Image size 2352x1568: 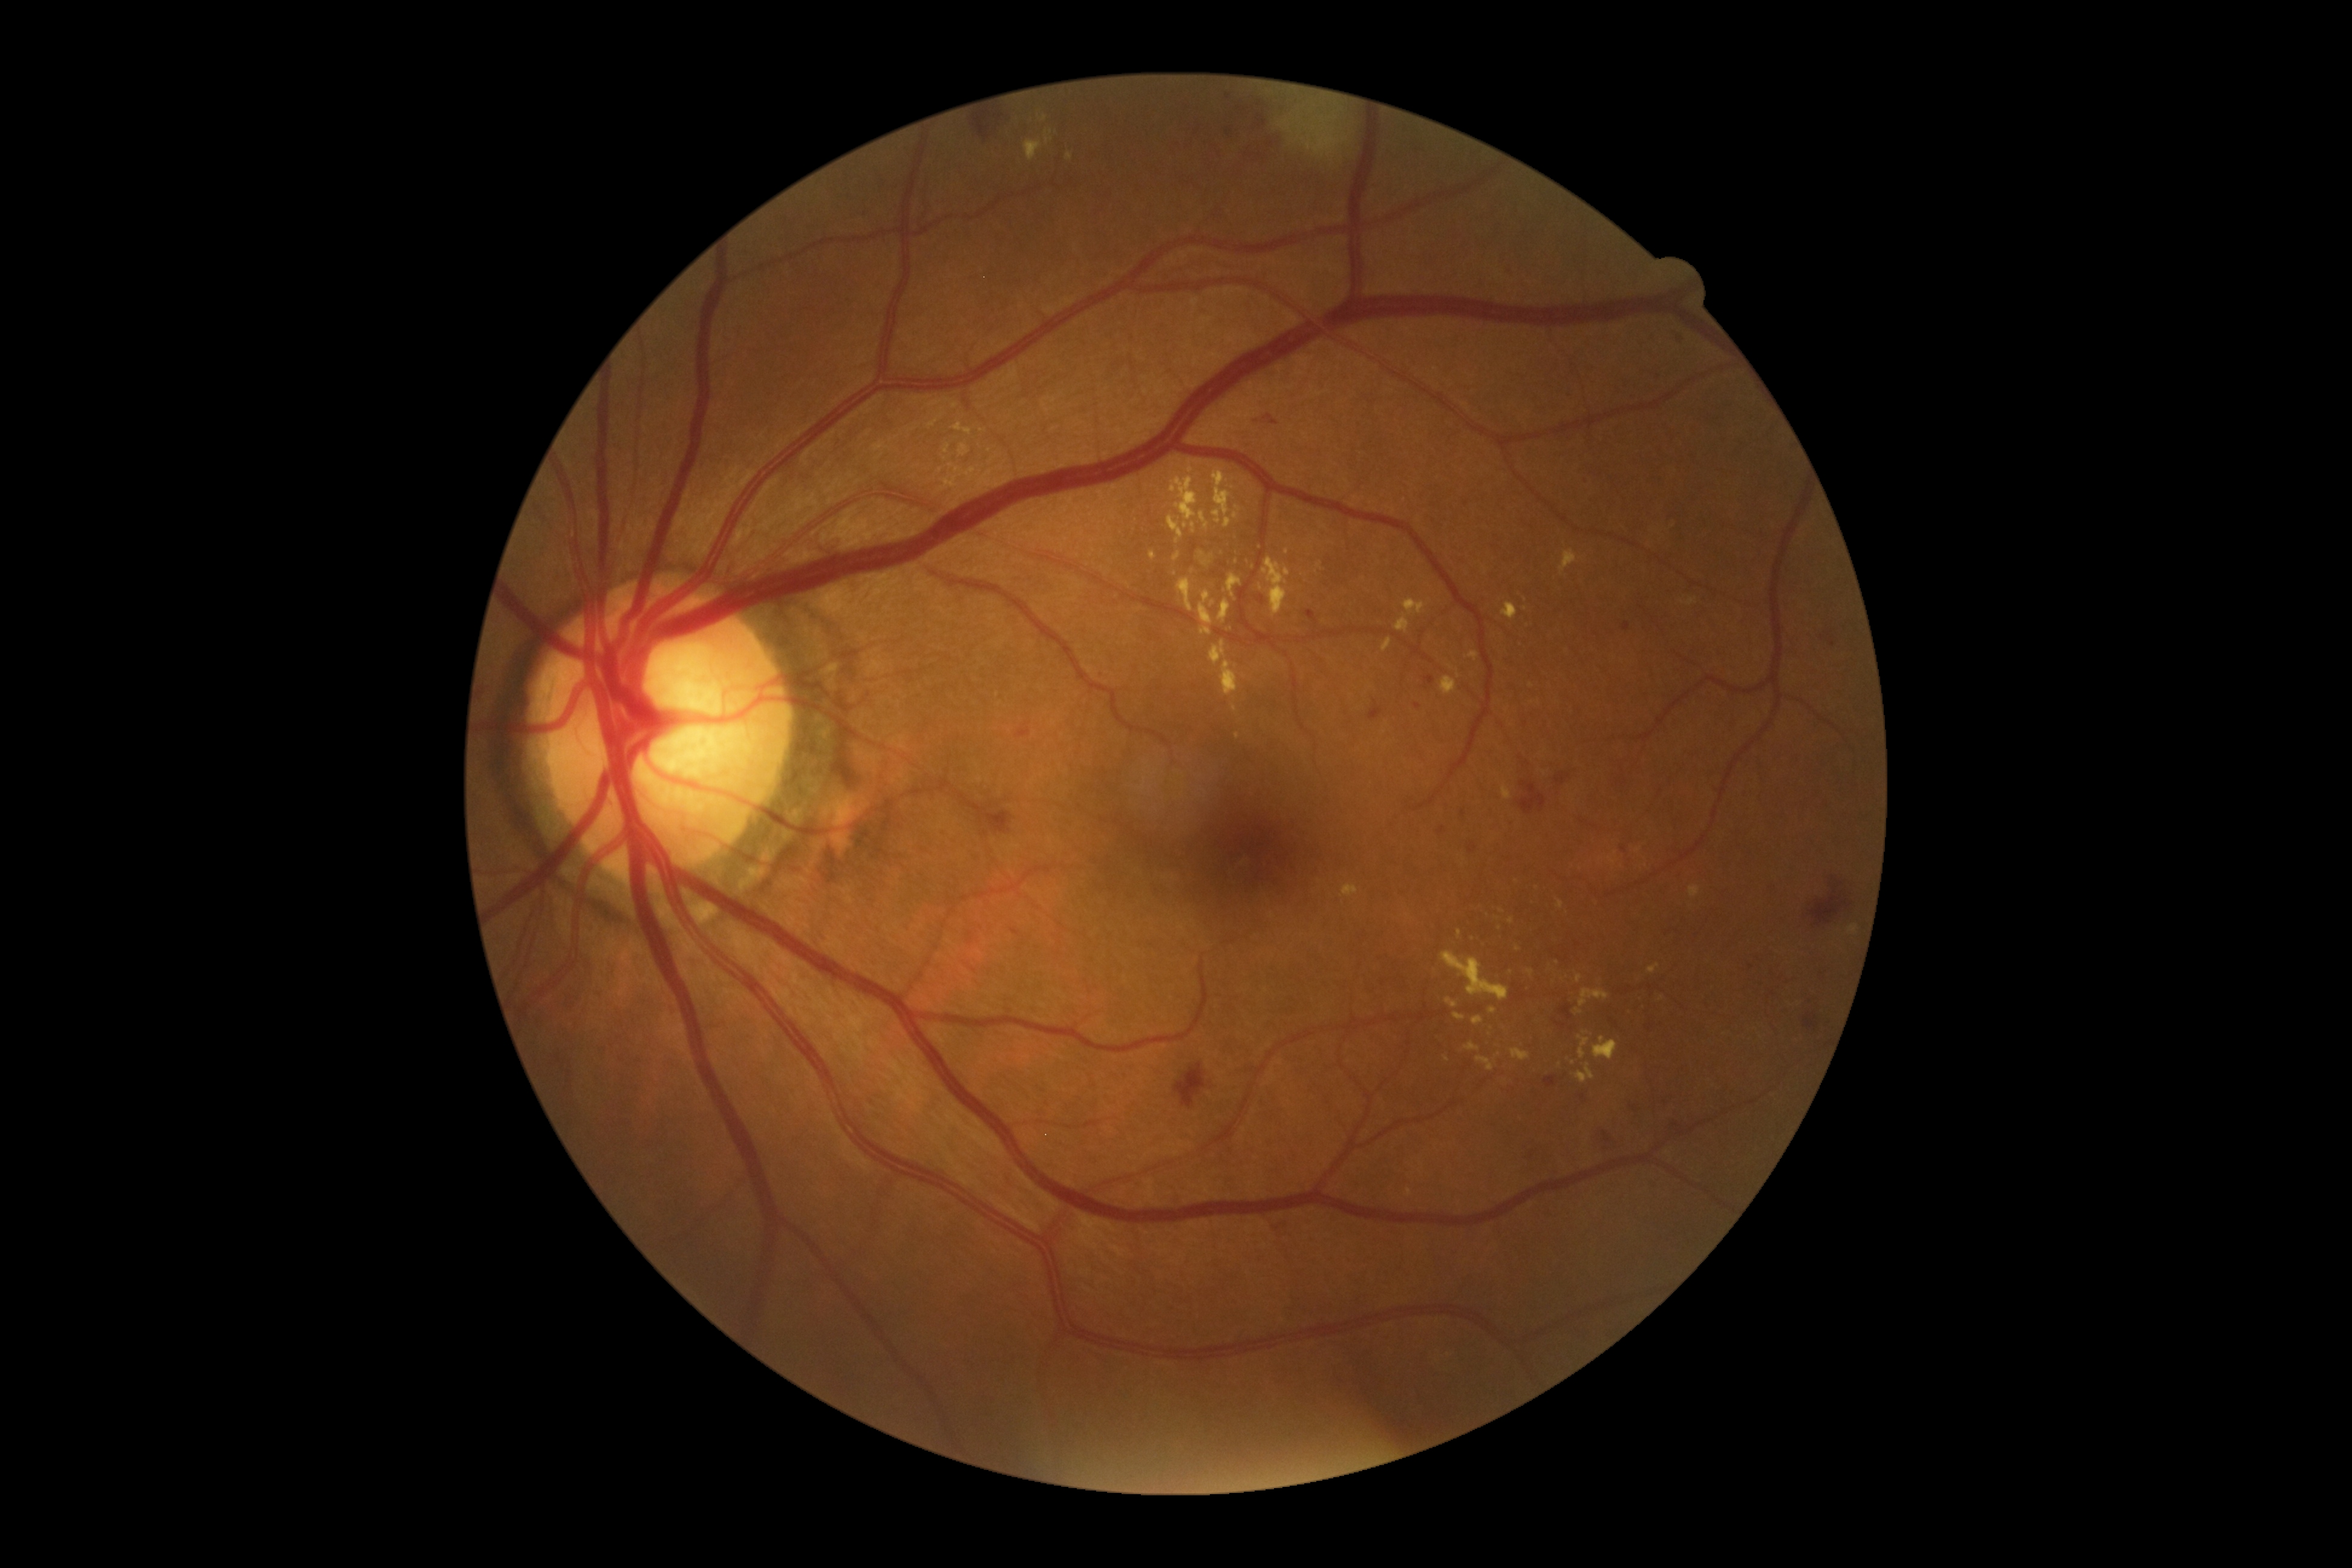

<lesions partial="true">
  <dr_grade>2</dr_grade>
  <se><bbox>1276, 90, 1352, 159</bbox></se>
  <ma partial="true"><bbox>1016, 724, 1030, 737</bbox> | <bbox>1630, 1105, 1639, 1111</bbox> | <bbox>1226, 128, 1233, 136</bbox> | <bbox>1468, 843, 1477, 854</bbox> | <bbox>1369, 699, 1382, 722</bbox> | <bbox>1011, 929, 1021, 936</bbox> | <bbox>1544, 1076, 1557, 1087</bbox></ma>
  <ma_small_centers>[x=1101, y=674] | [x=1417, y=706] | [x=1464, y=813] | [x=1228, y=97] | [x=1624, y=849]</ma_small_centers>
  <ex partial="true"><bbox>1465, 1042, 1480, 1051</bbox> | <bbox>1578, 988, 1610, 1006</bbox> | <bbox>1224, 574, 1242, 597</bbox> | <bbox>1454, 1012, 1466, 1021</bbox> | <bbox>1501, 602, 1518, 620</bbox> | <bbox>1489, 1007, 1497, 1013</bbox> | <bbox>942, 464, 976, 491</bbox> | <bbox>1442, 950, 1509, 1001</bbox> | <bbox>1557, 900, 1564, 909</bbox> | <bbox>1202, 560, 1210, 567</bbox> | <bbox>958, 442, 971, 457</bbox></ex>
  <ex_small_centers>[x=950, y=455] | [x=1557, y=962] | [x=1236, y=666] | [x=945, y=459] | [x=1191, y=471] | [x=1238, y=736]</ex_small_centers>
  <he><bbox>1253, 111, 1267, 130</bbox> | <bbox>985, 809, 1013, 834</bbox> | <bbox>1555, 773, 1571, 786</bbox> | <bbox>1264, 416, 1278, 425</bbox> | <bbox>1805, 1013, 1819, 1029</bbox> | <bbox>972, 108, 991, 141</bbox> | <bbox>1258, 102, 1266, 107</bbox> | <bbox>1821, 632, 1835, 648</bbox> | <bbox>1809, 885, 1852, 927</bbox> | <bbox>1602, 1131, 1612, 1143</bbox> | <bbox>994, 114, 1004, 122</bbox> | <bbox>1243, 148, 1260, 159</bbox> | <bbox>1519, 781, 1547, 815</bbox> | <bbox>1174, 1062, 1206, 1108</bbox> | <bbox>1266, 137, 1275, 148</bbox></he>
</lesions>